45 degree fundus photograph
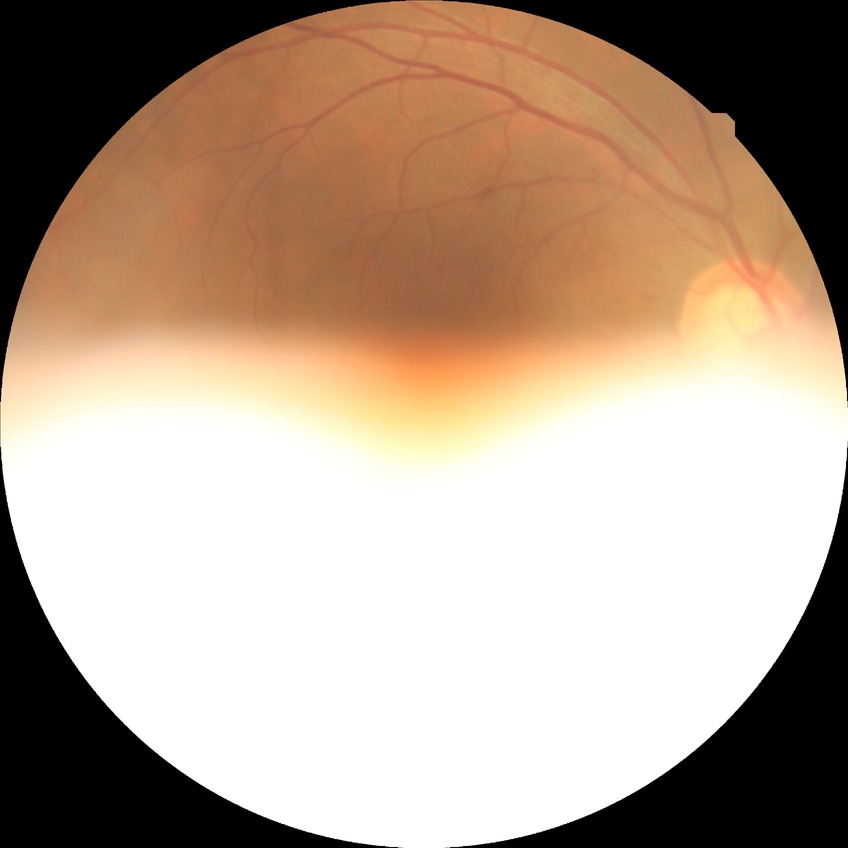

Diabetic retinopathy severity is no diabetic retinopathy.